FOV: 45 degrees; CFP; image size 2184x1690
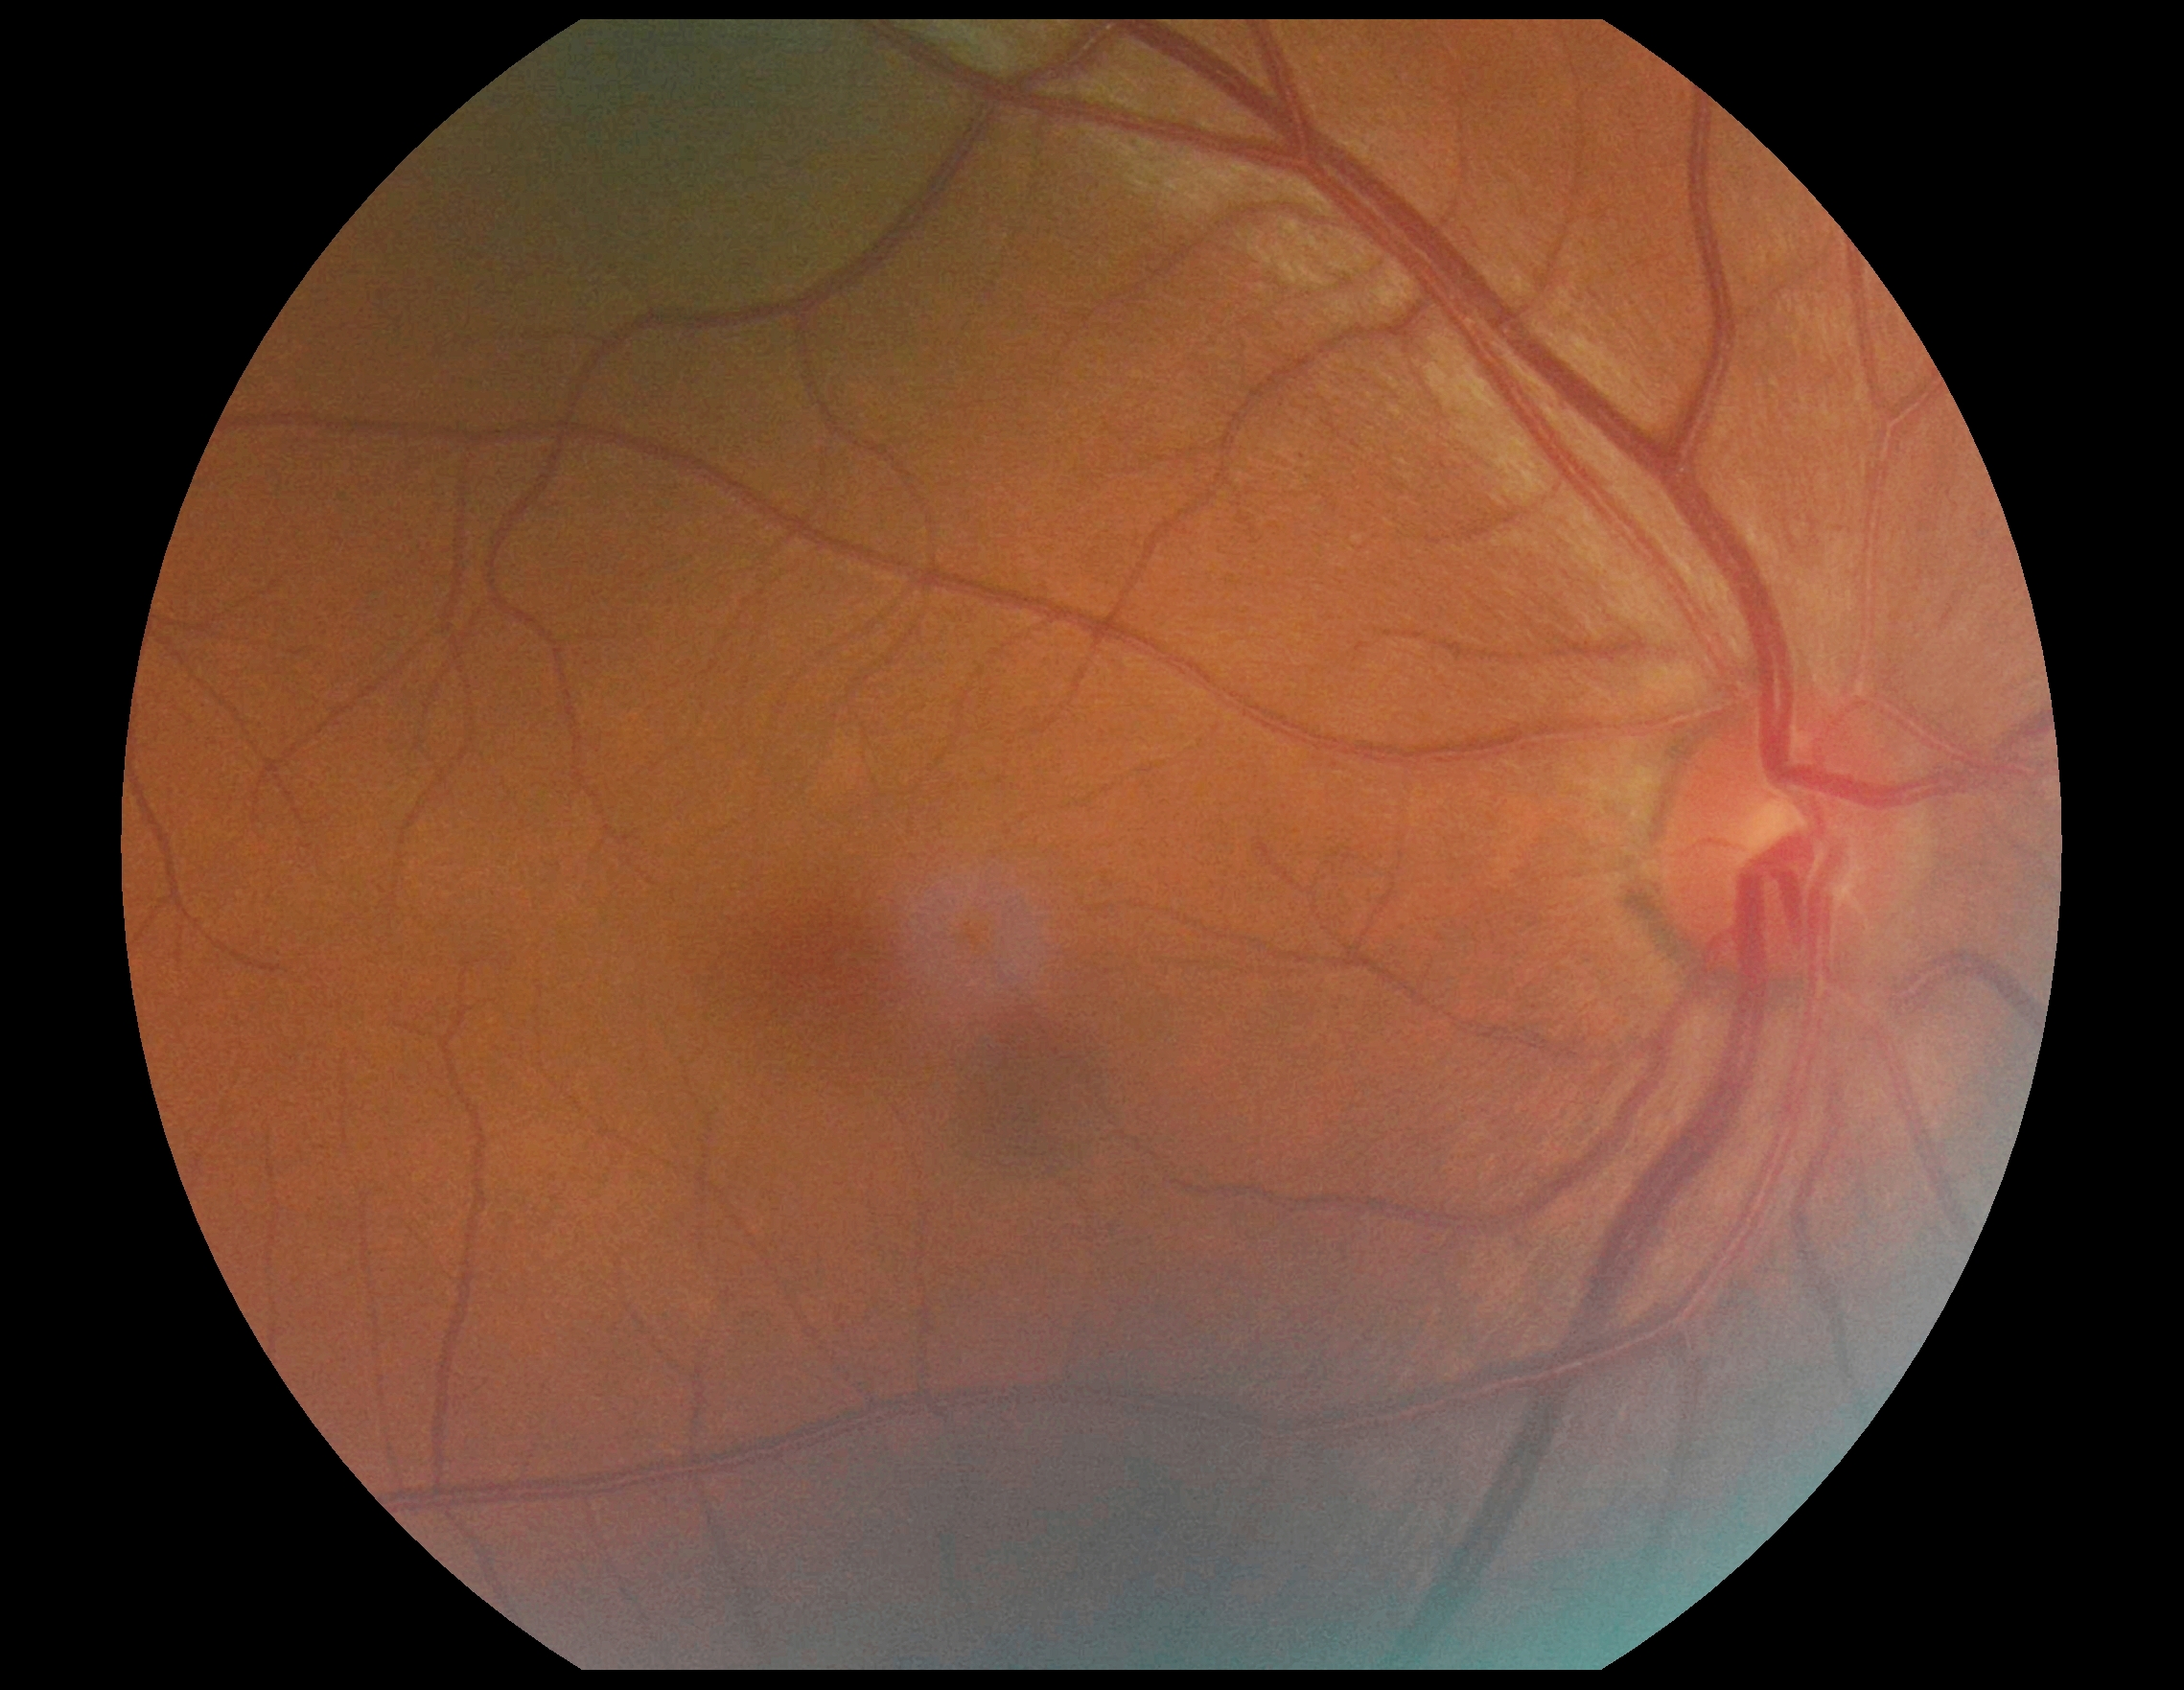 Diabetic retinopathy grade is 0.